2212x1659px: 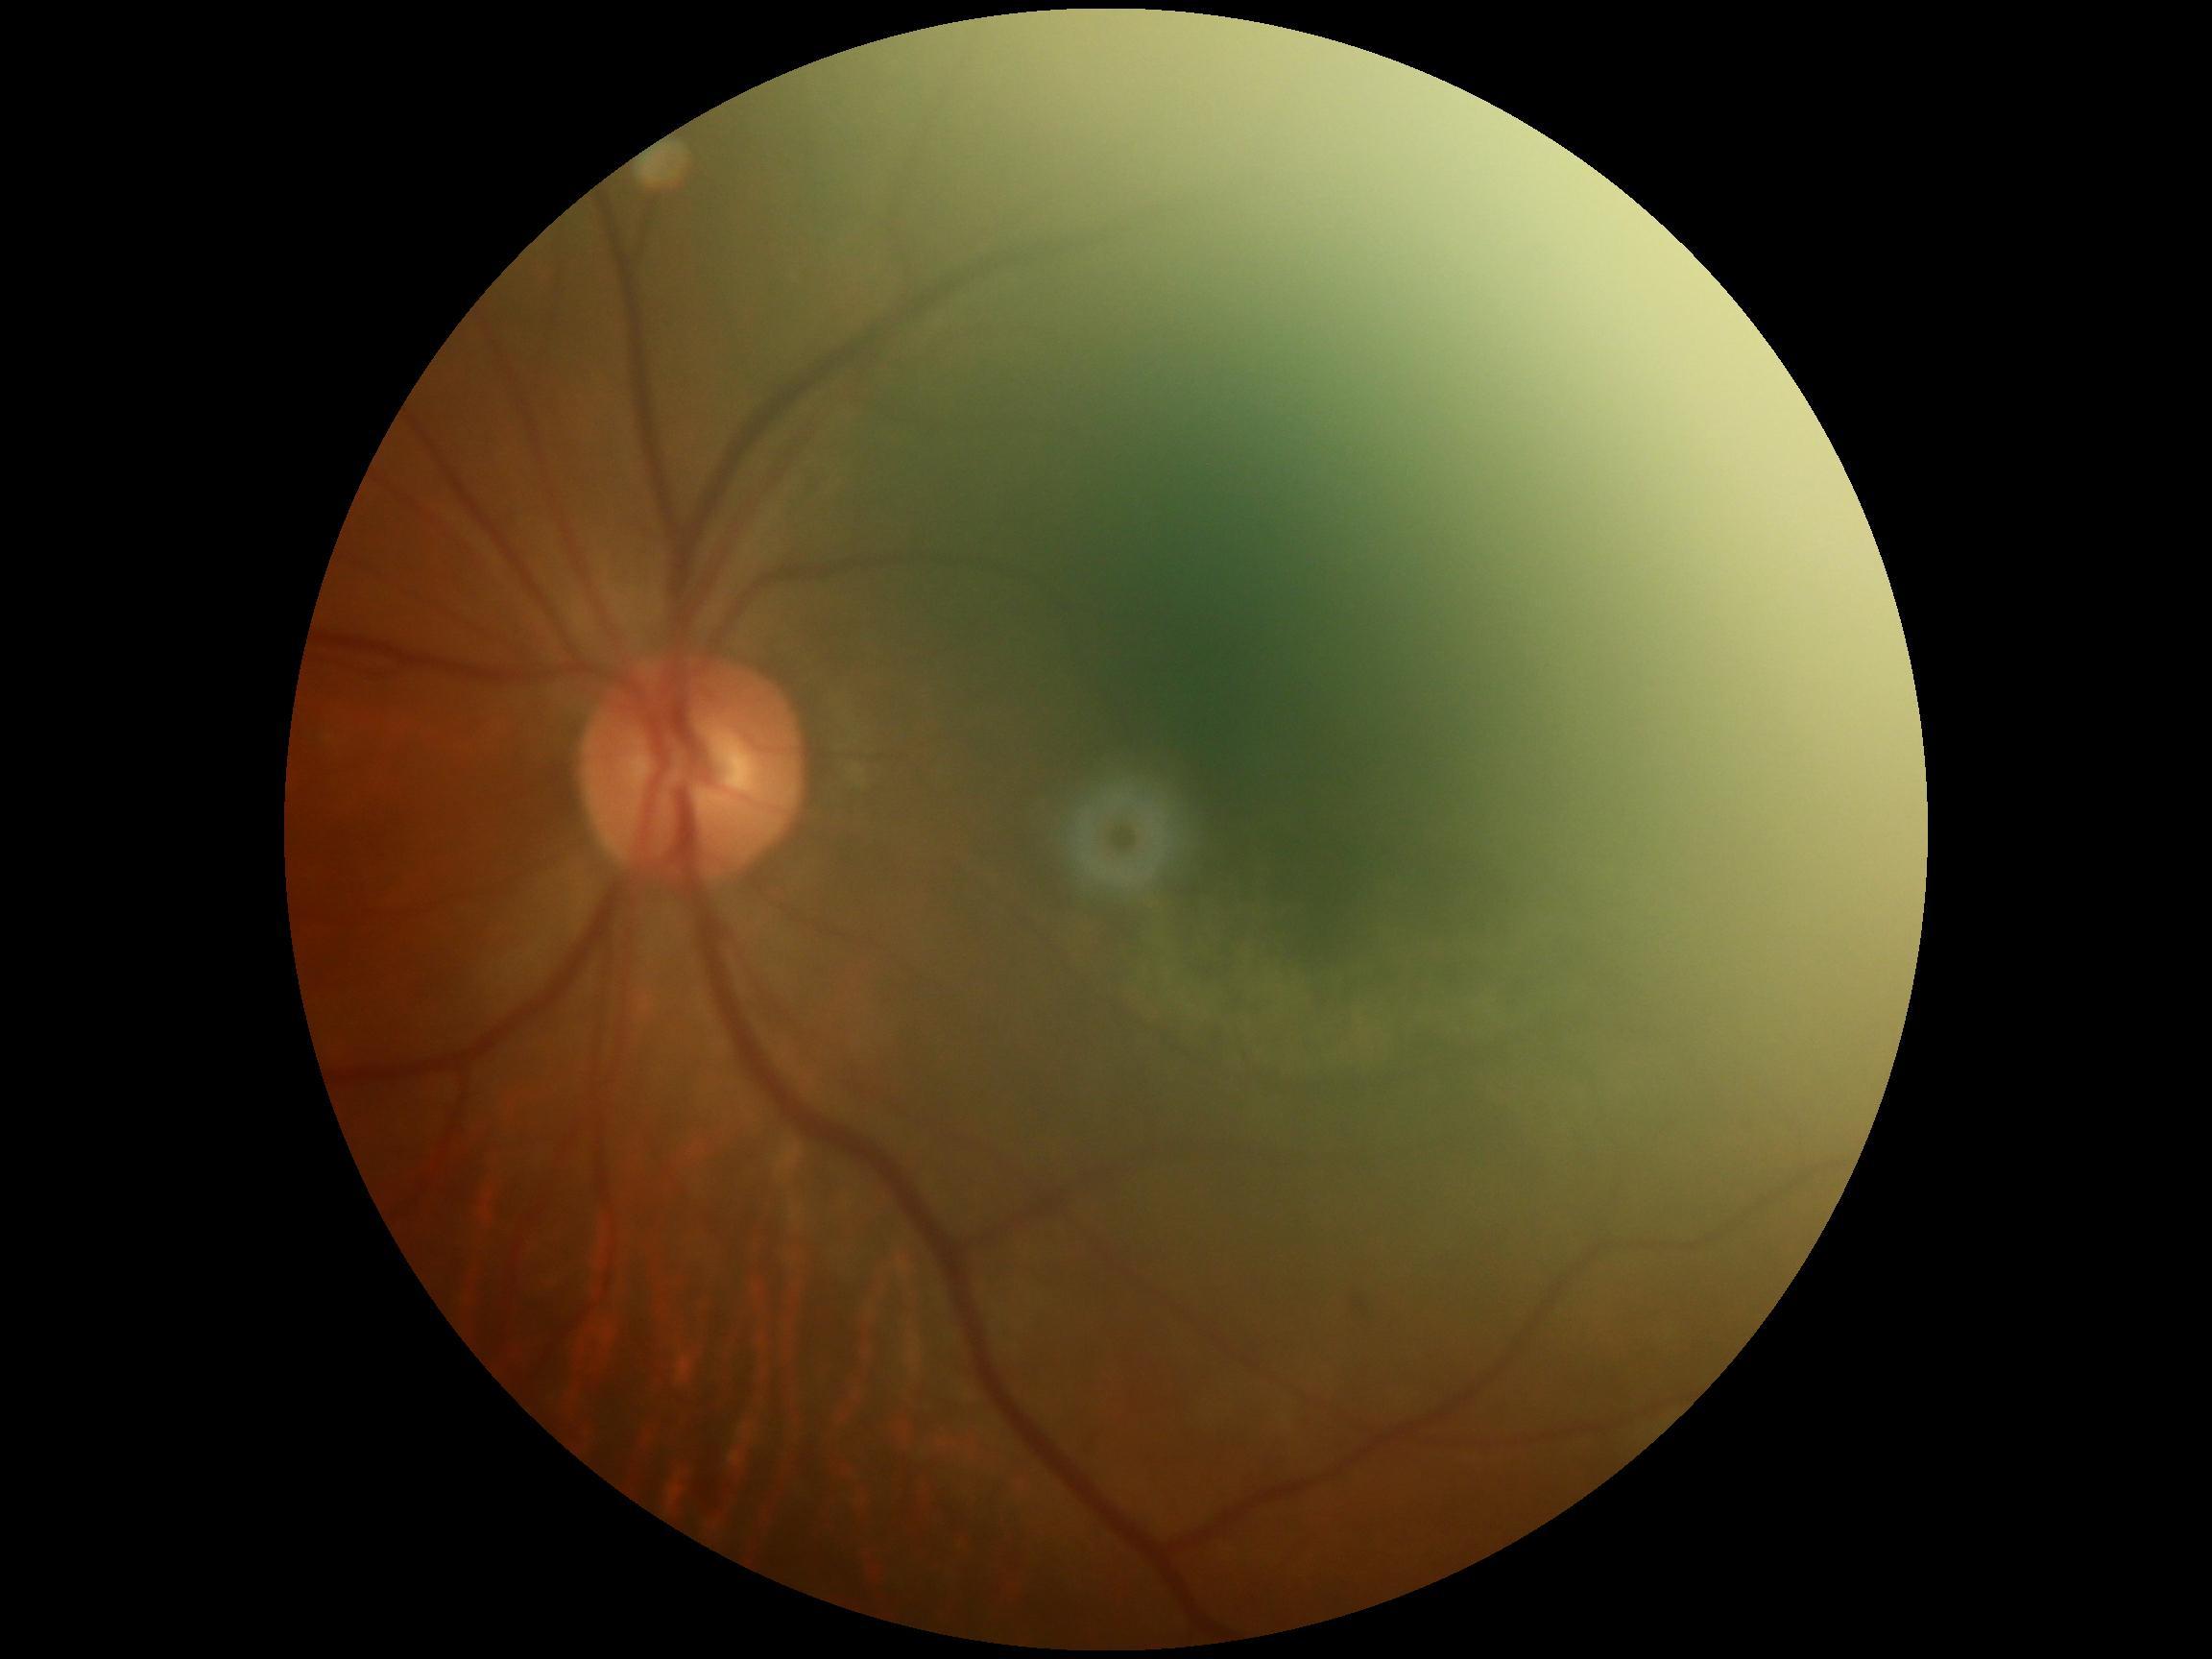 DR stage is 2.